45 degree fundus photograph; CFP; without pupil dilation; image size 848x848 — 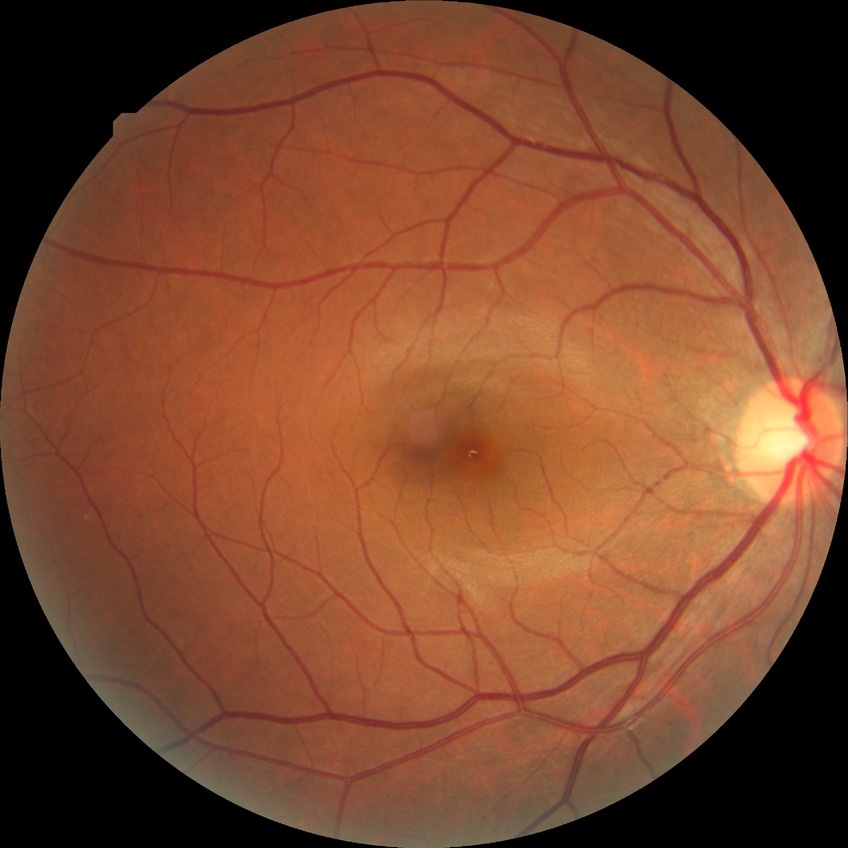
Diabetic retinopathy stage: no diabetic retinopathy.